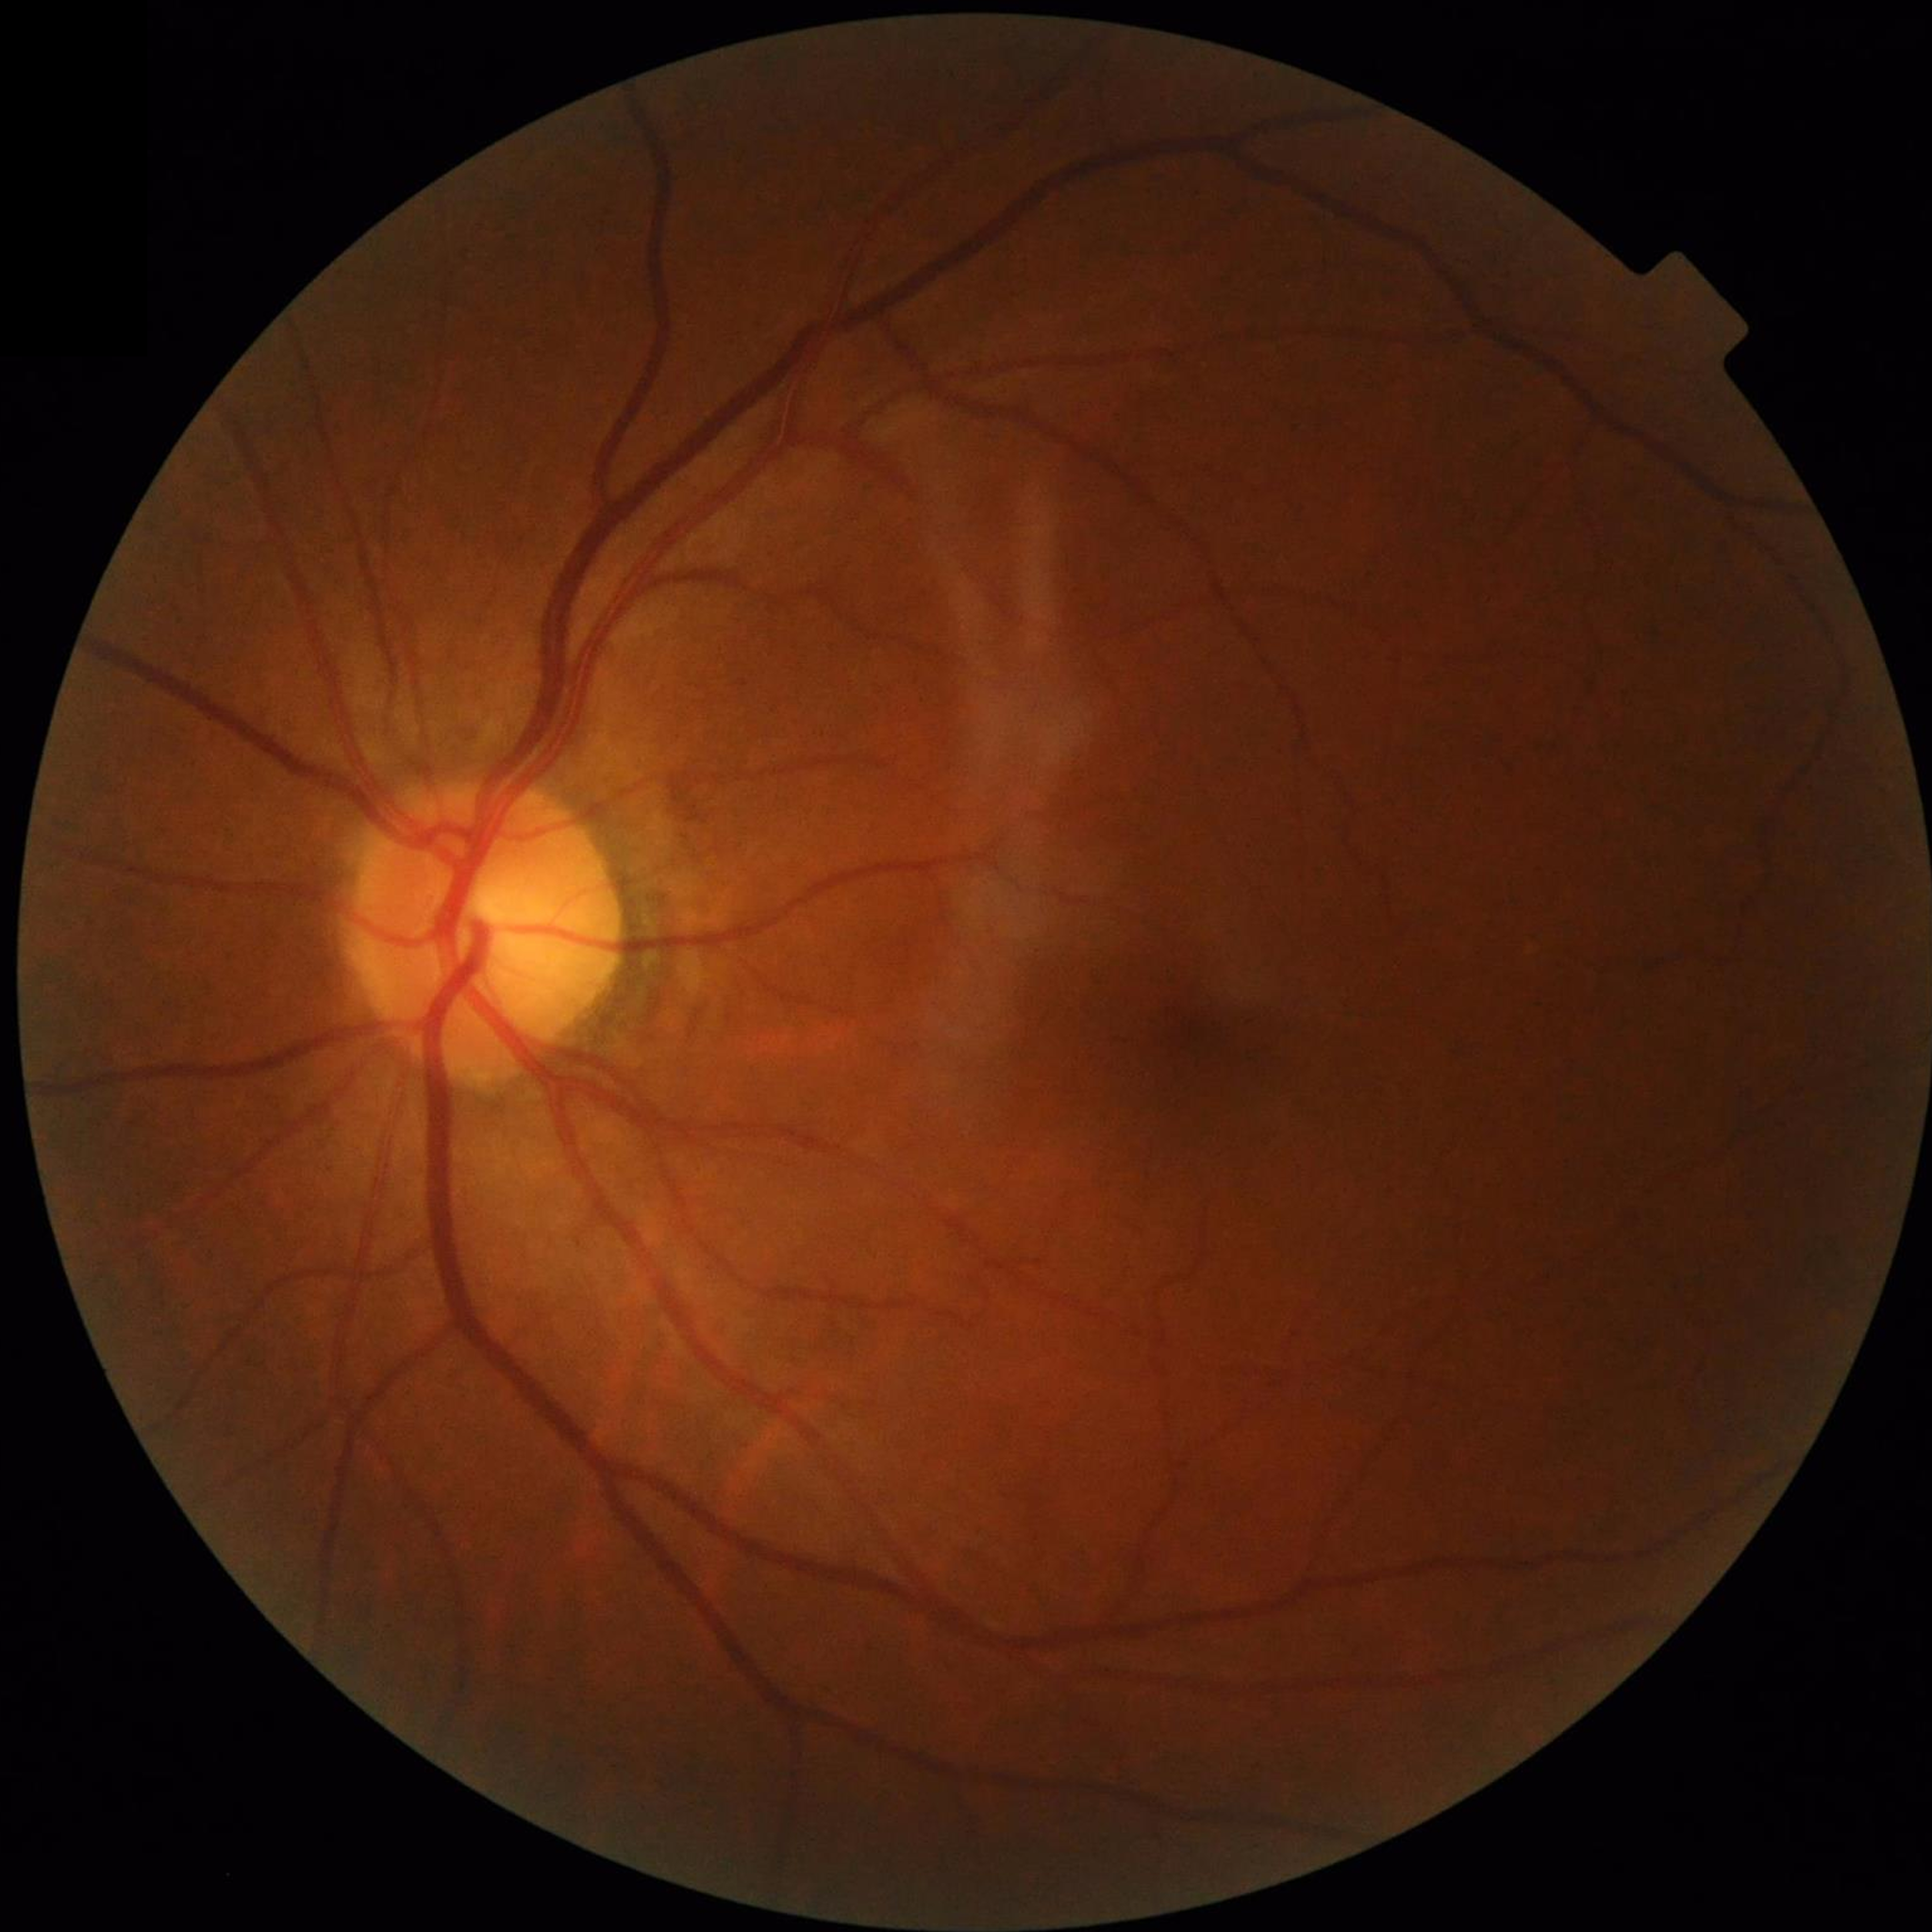
Disease class: no AMD, DR, or glaucomatous findings.